Pediatric retinal photograph (wide-field).
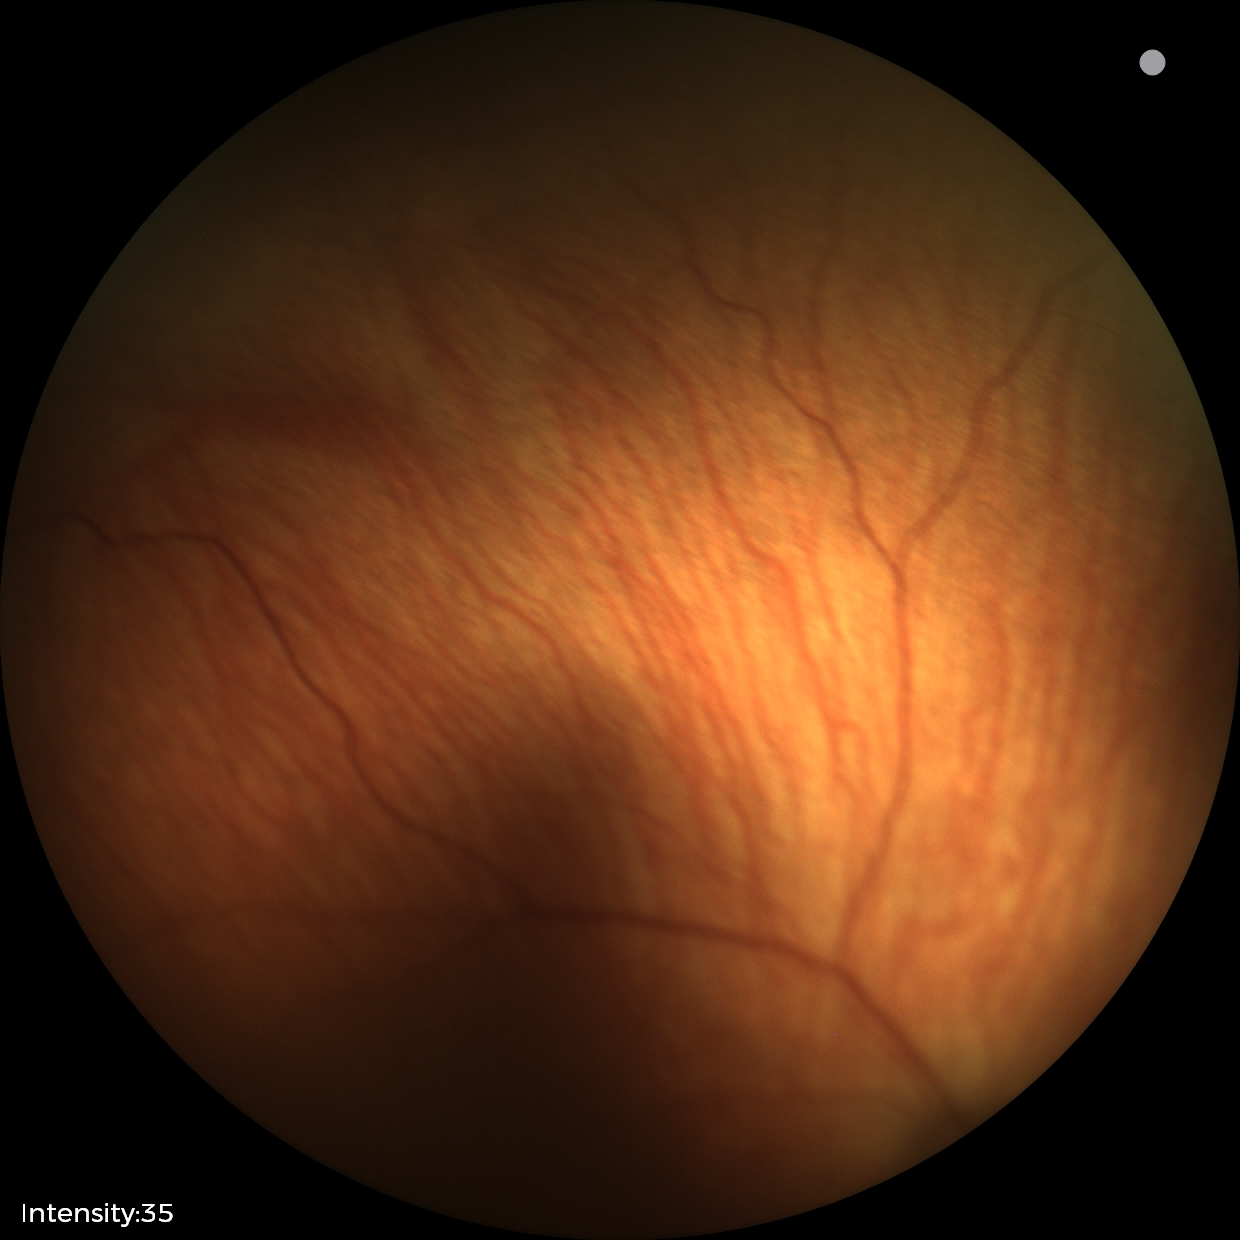

Plus disease absent. Screening series with status post ROP.